45-degree field of view · 2048x1536 — 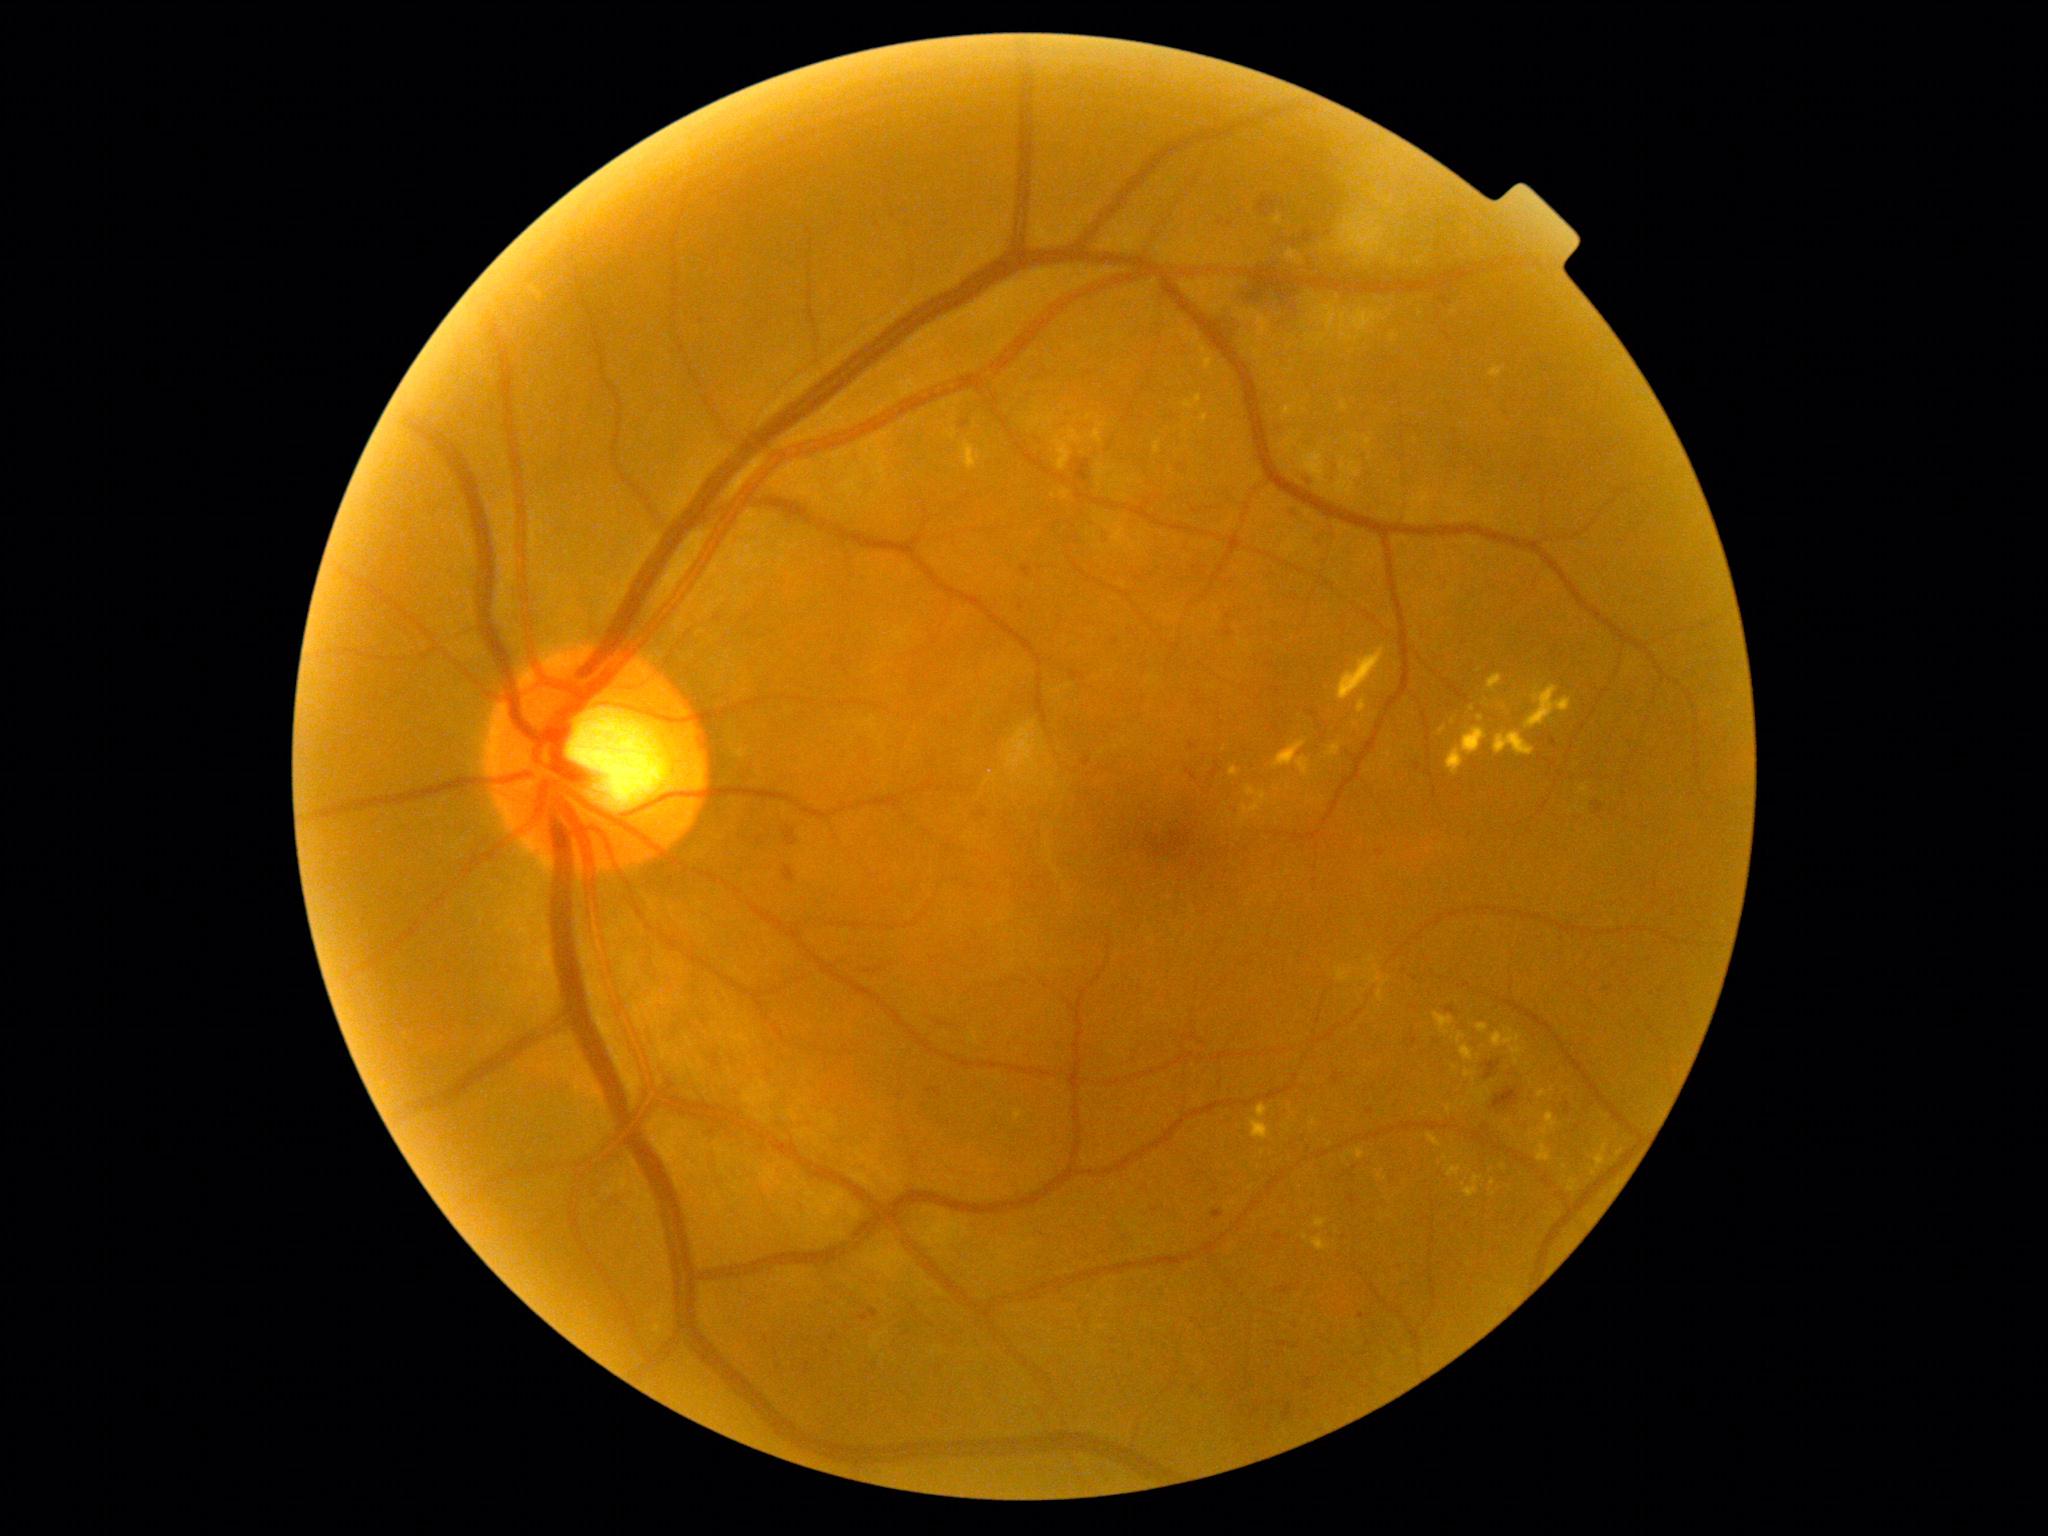 DR: moderate non-proliferative diabetic retinopathy (grade 2)
Representative lesions:
MAs: [866, 1309, 880, 1317]; [1211, 1210, 1224, 1220]; [1273, 1234, 1283, 1241]; [1446, 1007, 1455, 1014]; [1415, 763, 1422, 772]; [1347, 1196, 1357, 1206]; [1332, 1071, 1346, 1084]; [1289, 508, 1302, 518]; [1357, 1313, 1370, 1319]; [1082, 757, 1091, 767]; [1549, 737, 1558, 747]; [1367, 1108, 1375, 1115]; [1021, 566, 1032, 578]
MAs (small, approximate centers) near (1608; 989); (1193; 746); (1309; 482)
SEs: none detected
EXs (continued): [1201, 414, 1208, 427]; [1014, 1110, 1024, 1121]; [1595, 1140, 1610, 1170]; [965, 438, 969, 470]; [1448, 1165, 1462, 1177]; [1365, 437, 1372, 445]; [1337, 647, 1385, 700]; [1537, 1111, 1559, 1163]; [1461, 1045, 1475, 1061]; [1357, 699, 1367, 713]; [1492, 1028, 1522, 1048]; [1312, 1236, 1330, 1251]
EXs (small, approximate centers) near (1620; 1153); (1455; 1067); (1552; 1089); (1473; 709); (1480; 671)
HEs: [1485, 1061, 1501, 1080]; [1489, 1087, 1519, 1112]; [1283, 1405, 1293, 1422]; [1077, 460, 1090, 481]; [1097, 533, 1108, 543]; [1376, 849, 1385, 858]; [1283, 503, 1307, 517]; [783, 826, 797, 846]; [1303, 231, 1314, 243]; [1224, 627, 1234, 637]; [1277, 1342, 1289, 1347]; [1231, 275, 1292, 314]; [1304, 1379, 1313, 1390]; [1257, 196, 1277, 218]; [1592, 802, 1604, 813]; [783, 865, 796, 882]; [1276, 1284, 1293, 1294]
HEs (small, approximate centers) near (965; 424)